Wide-field fundus photograph from neonatal ROP screening. 640 x 480 pixels:
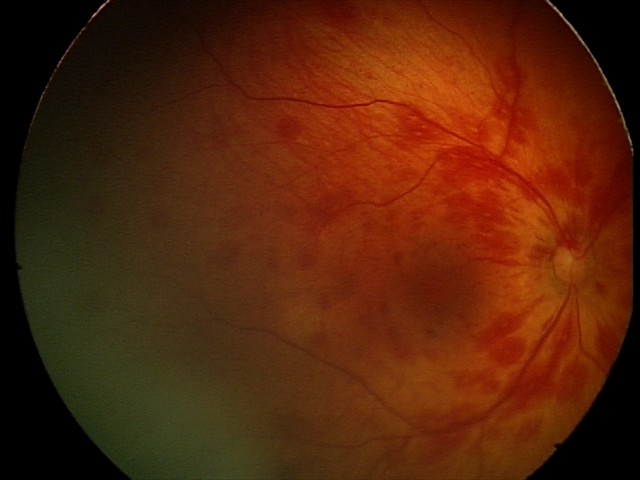

Assessment = retinal hemorrhages.